1380x1382
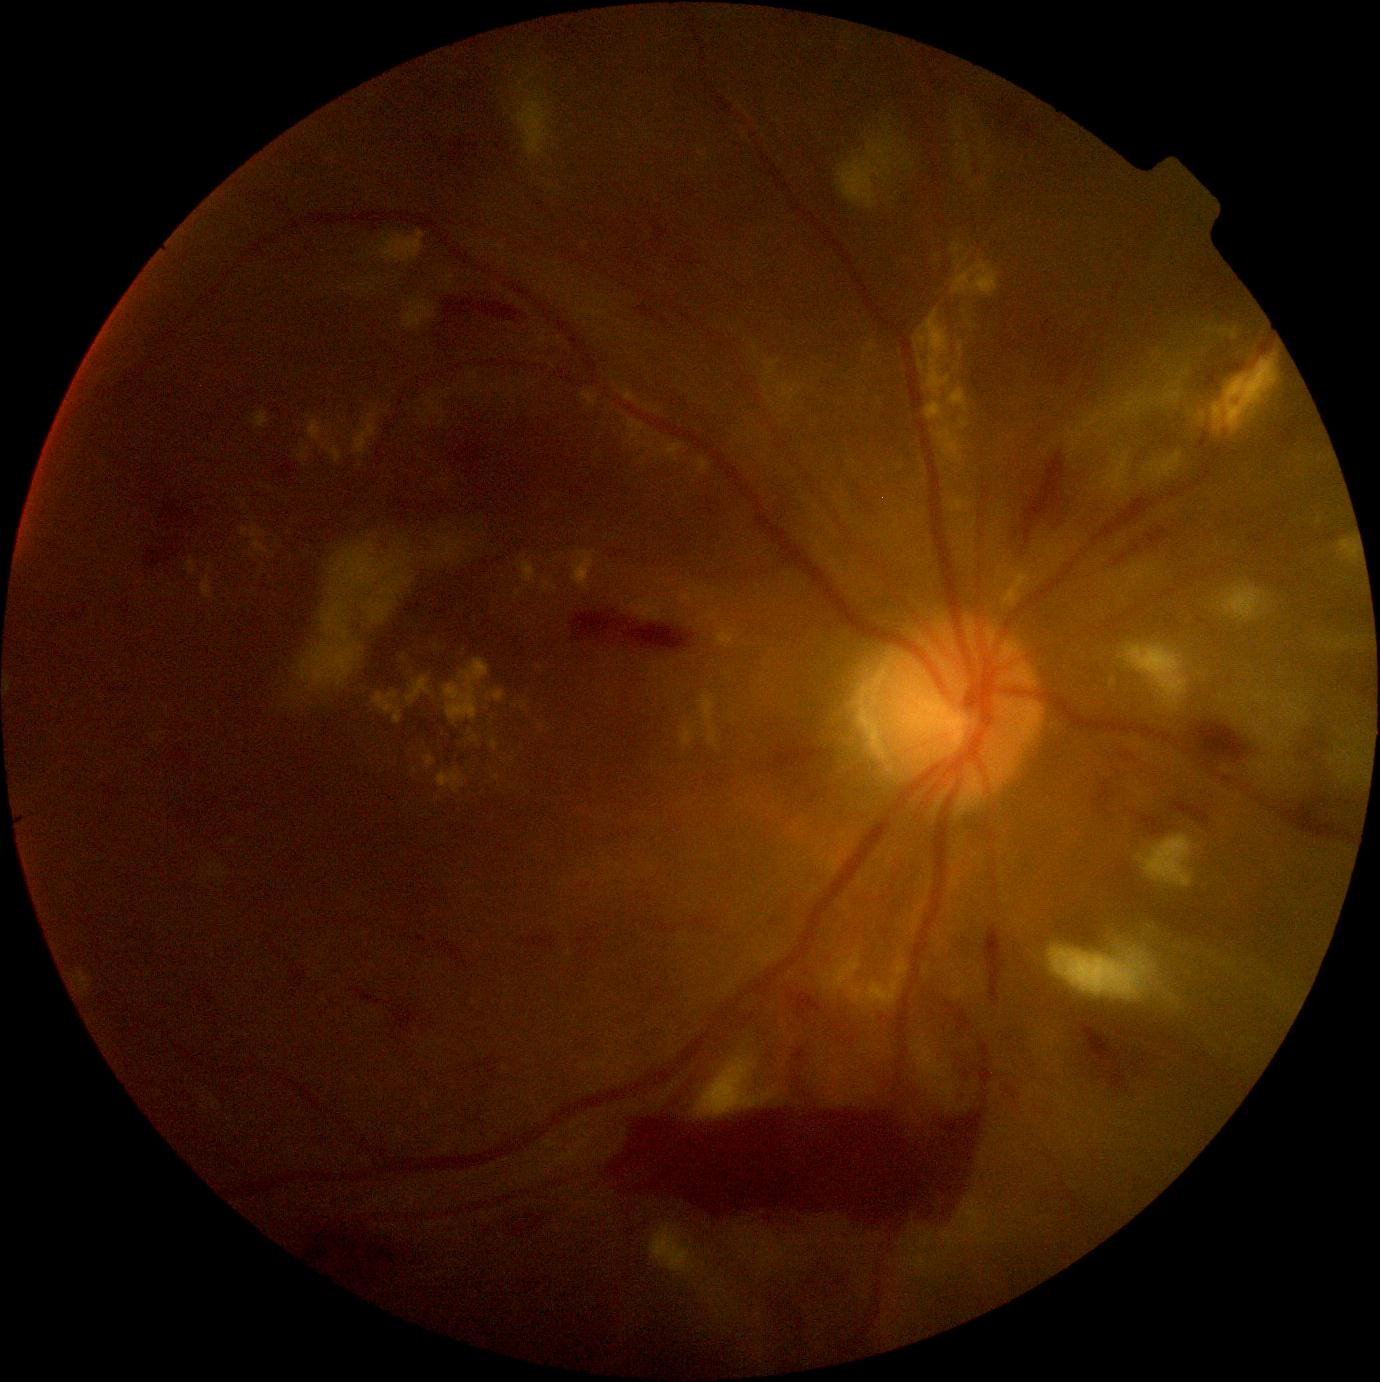

{"partial": true, "dr_grade": 4, "dr_grade_name": "PDR", "lesions": {"ex": [[572, 551, 598, 592], [717, 630, 734, 648], [679, 594, 695, 607], [299, 447, 309, 460], [1207, 325, 1239, 339], [187, 557, 196, 575], [1004, 575, 1028, 610], [516, 591, 521, 599], [951, 243, 1000, 298], [401, 654, 408, 662], [202, 576, 213, 599]], "ex_small": [[332, 429], [437, 647], [485, 689], [677, 460], [415, 772]]}}